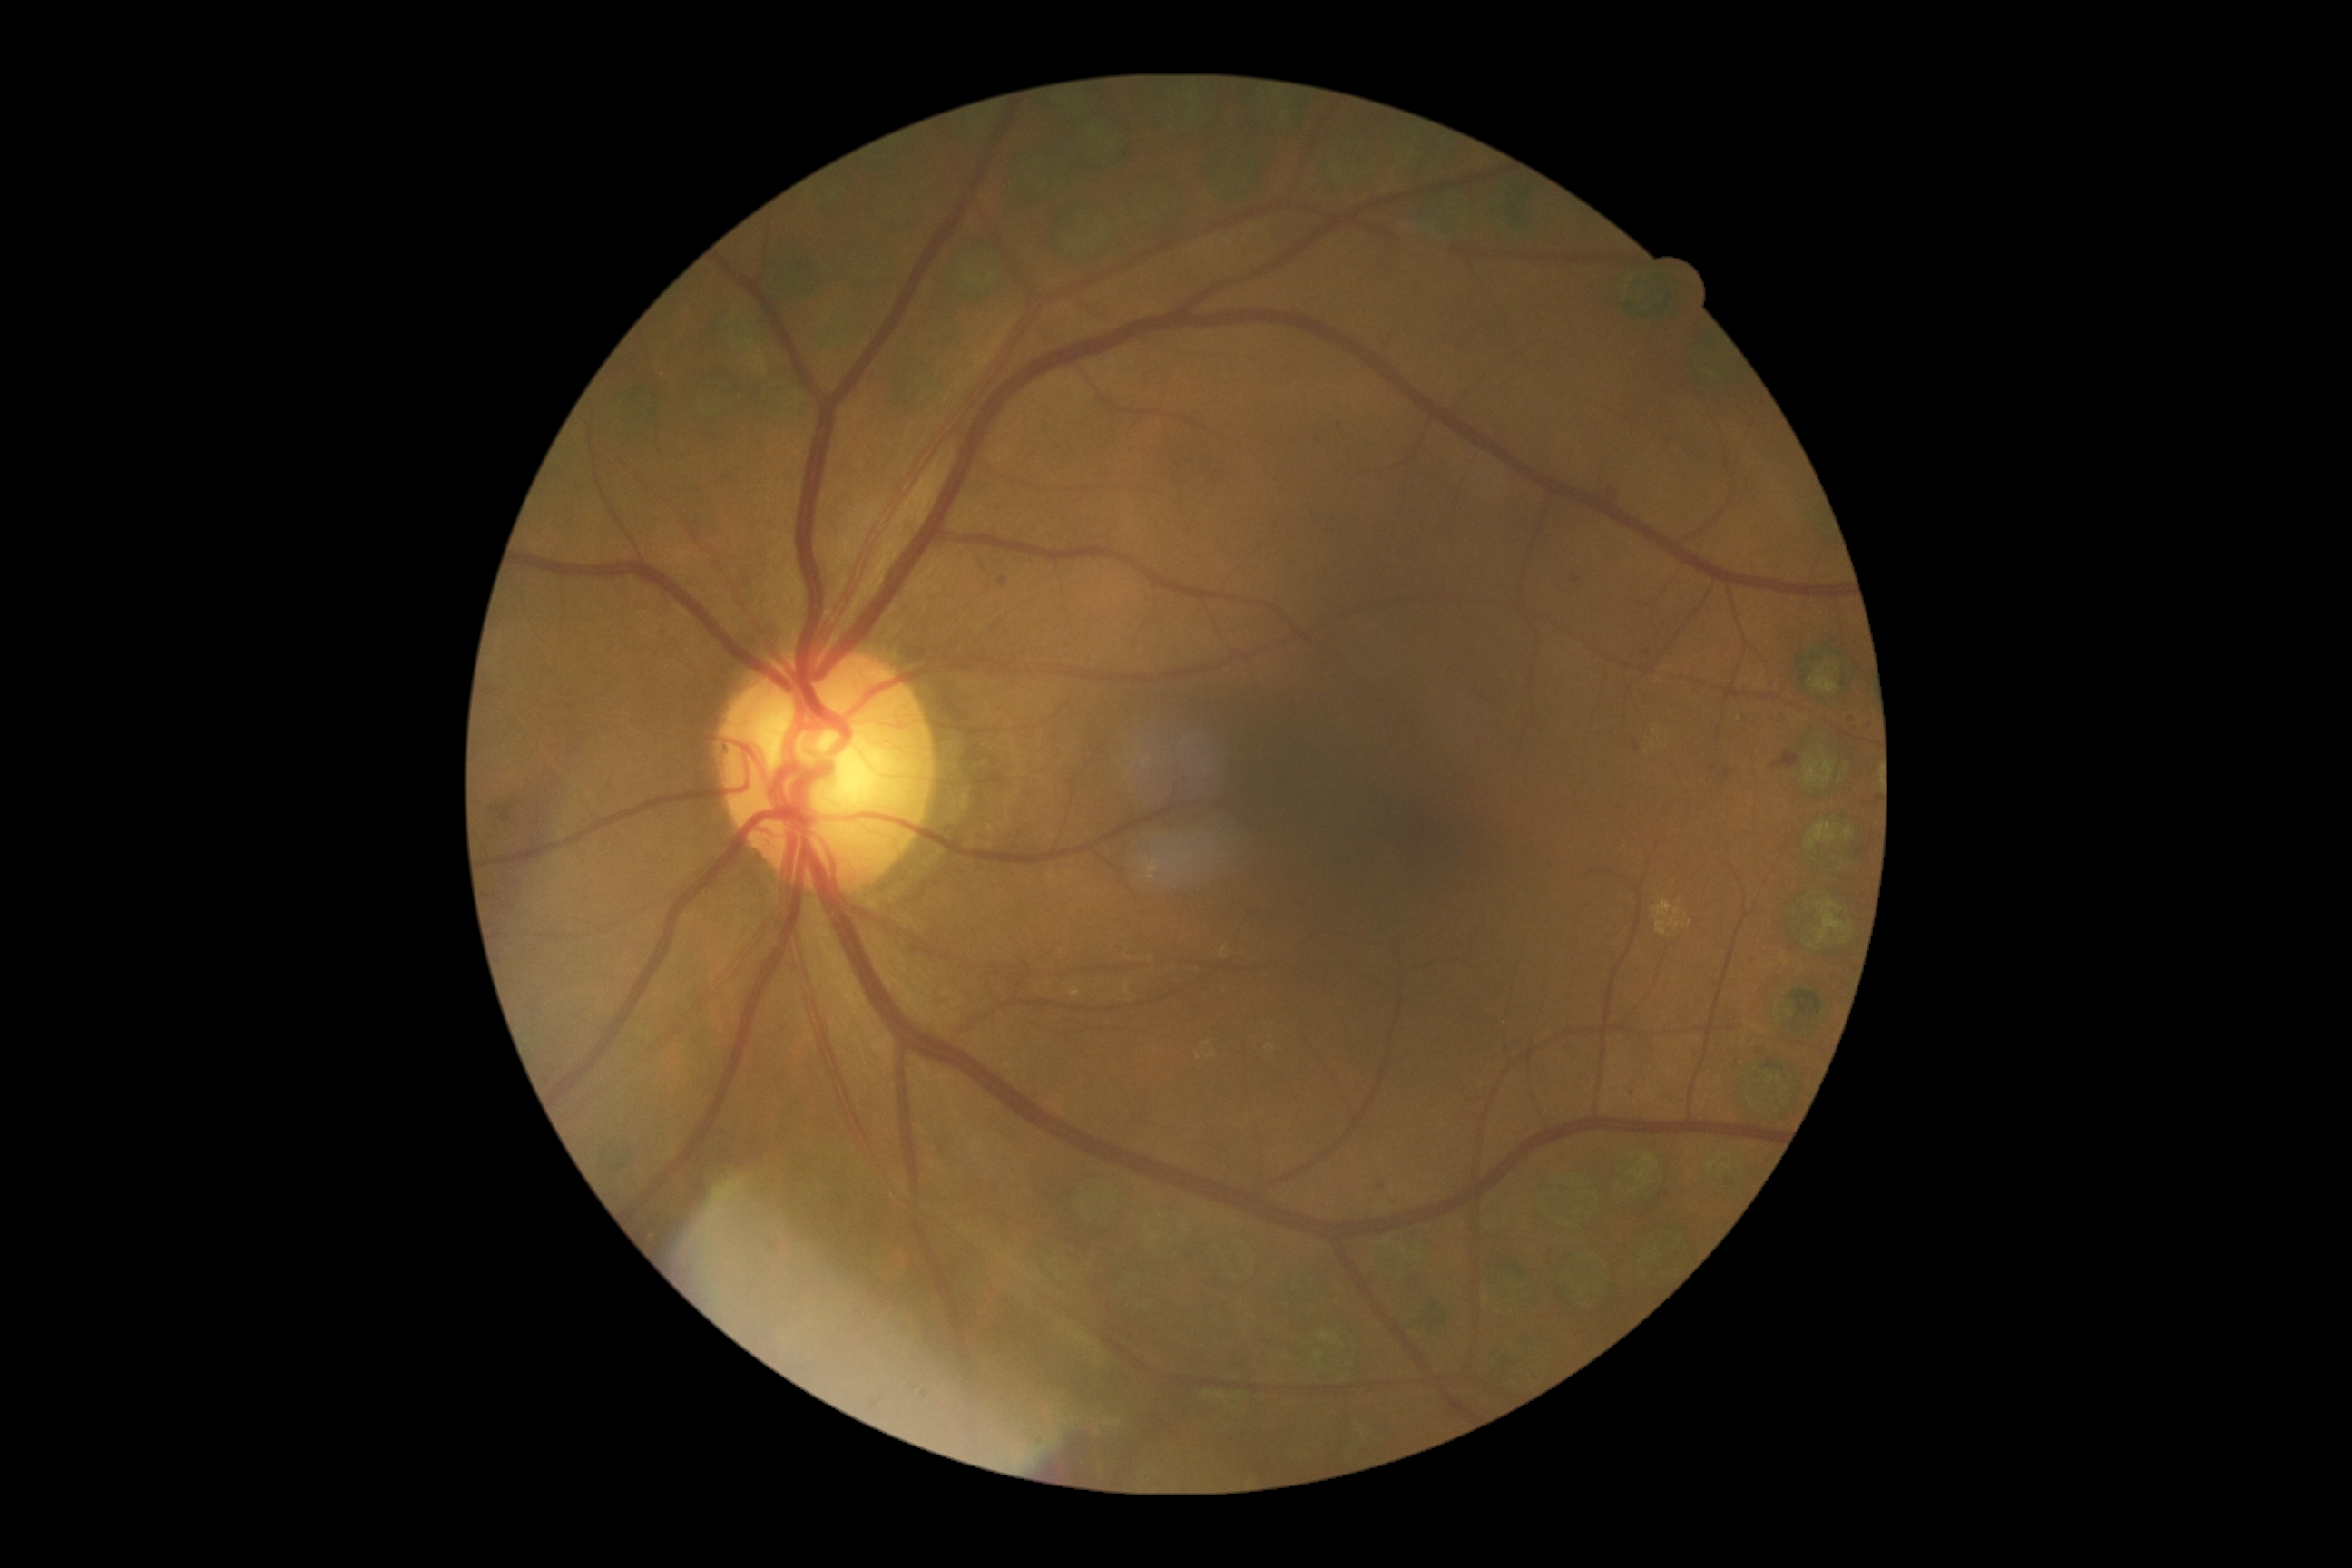 DR grade=moderate non-proliferative diabetic retinopathy (2), DR class=non-proliferative diabetic retinopathy.